DR severity per modified Davis staging.
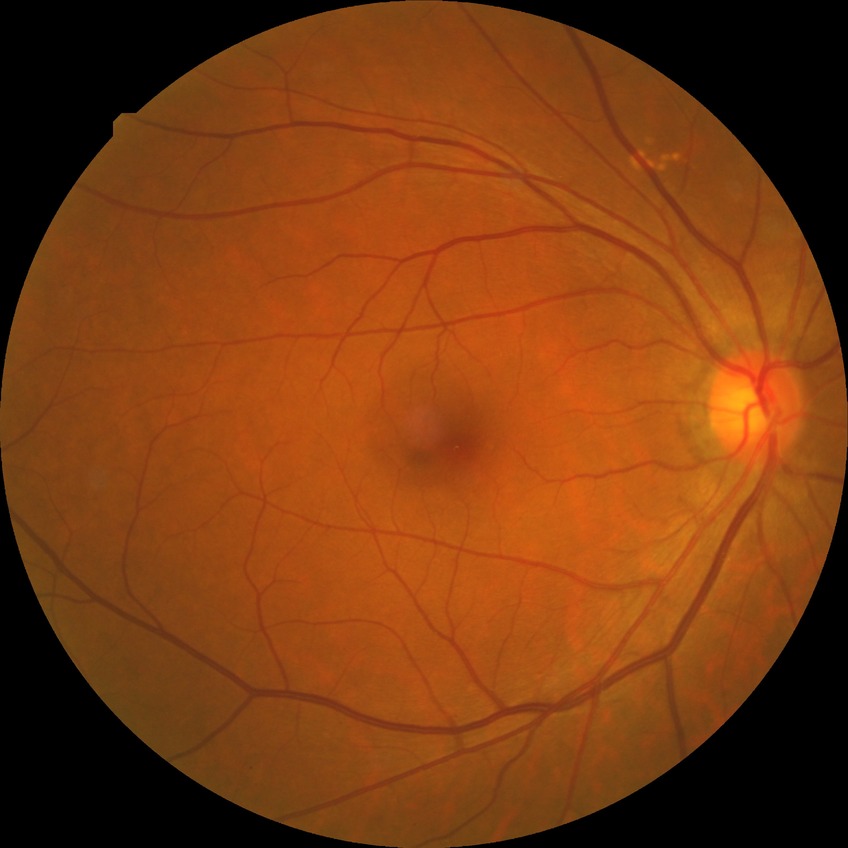 Diabetic retinopathy (DR): no diabetic retinopathy (NDR).